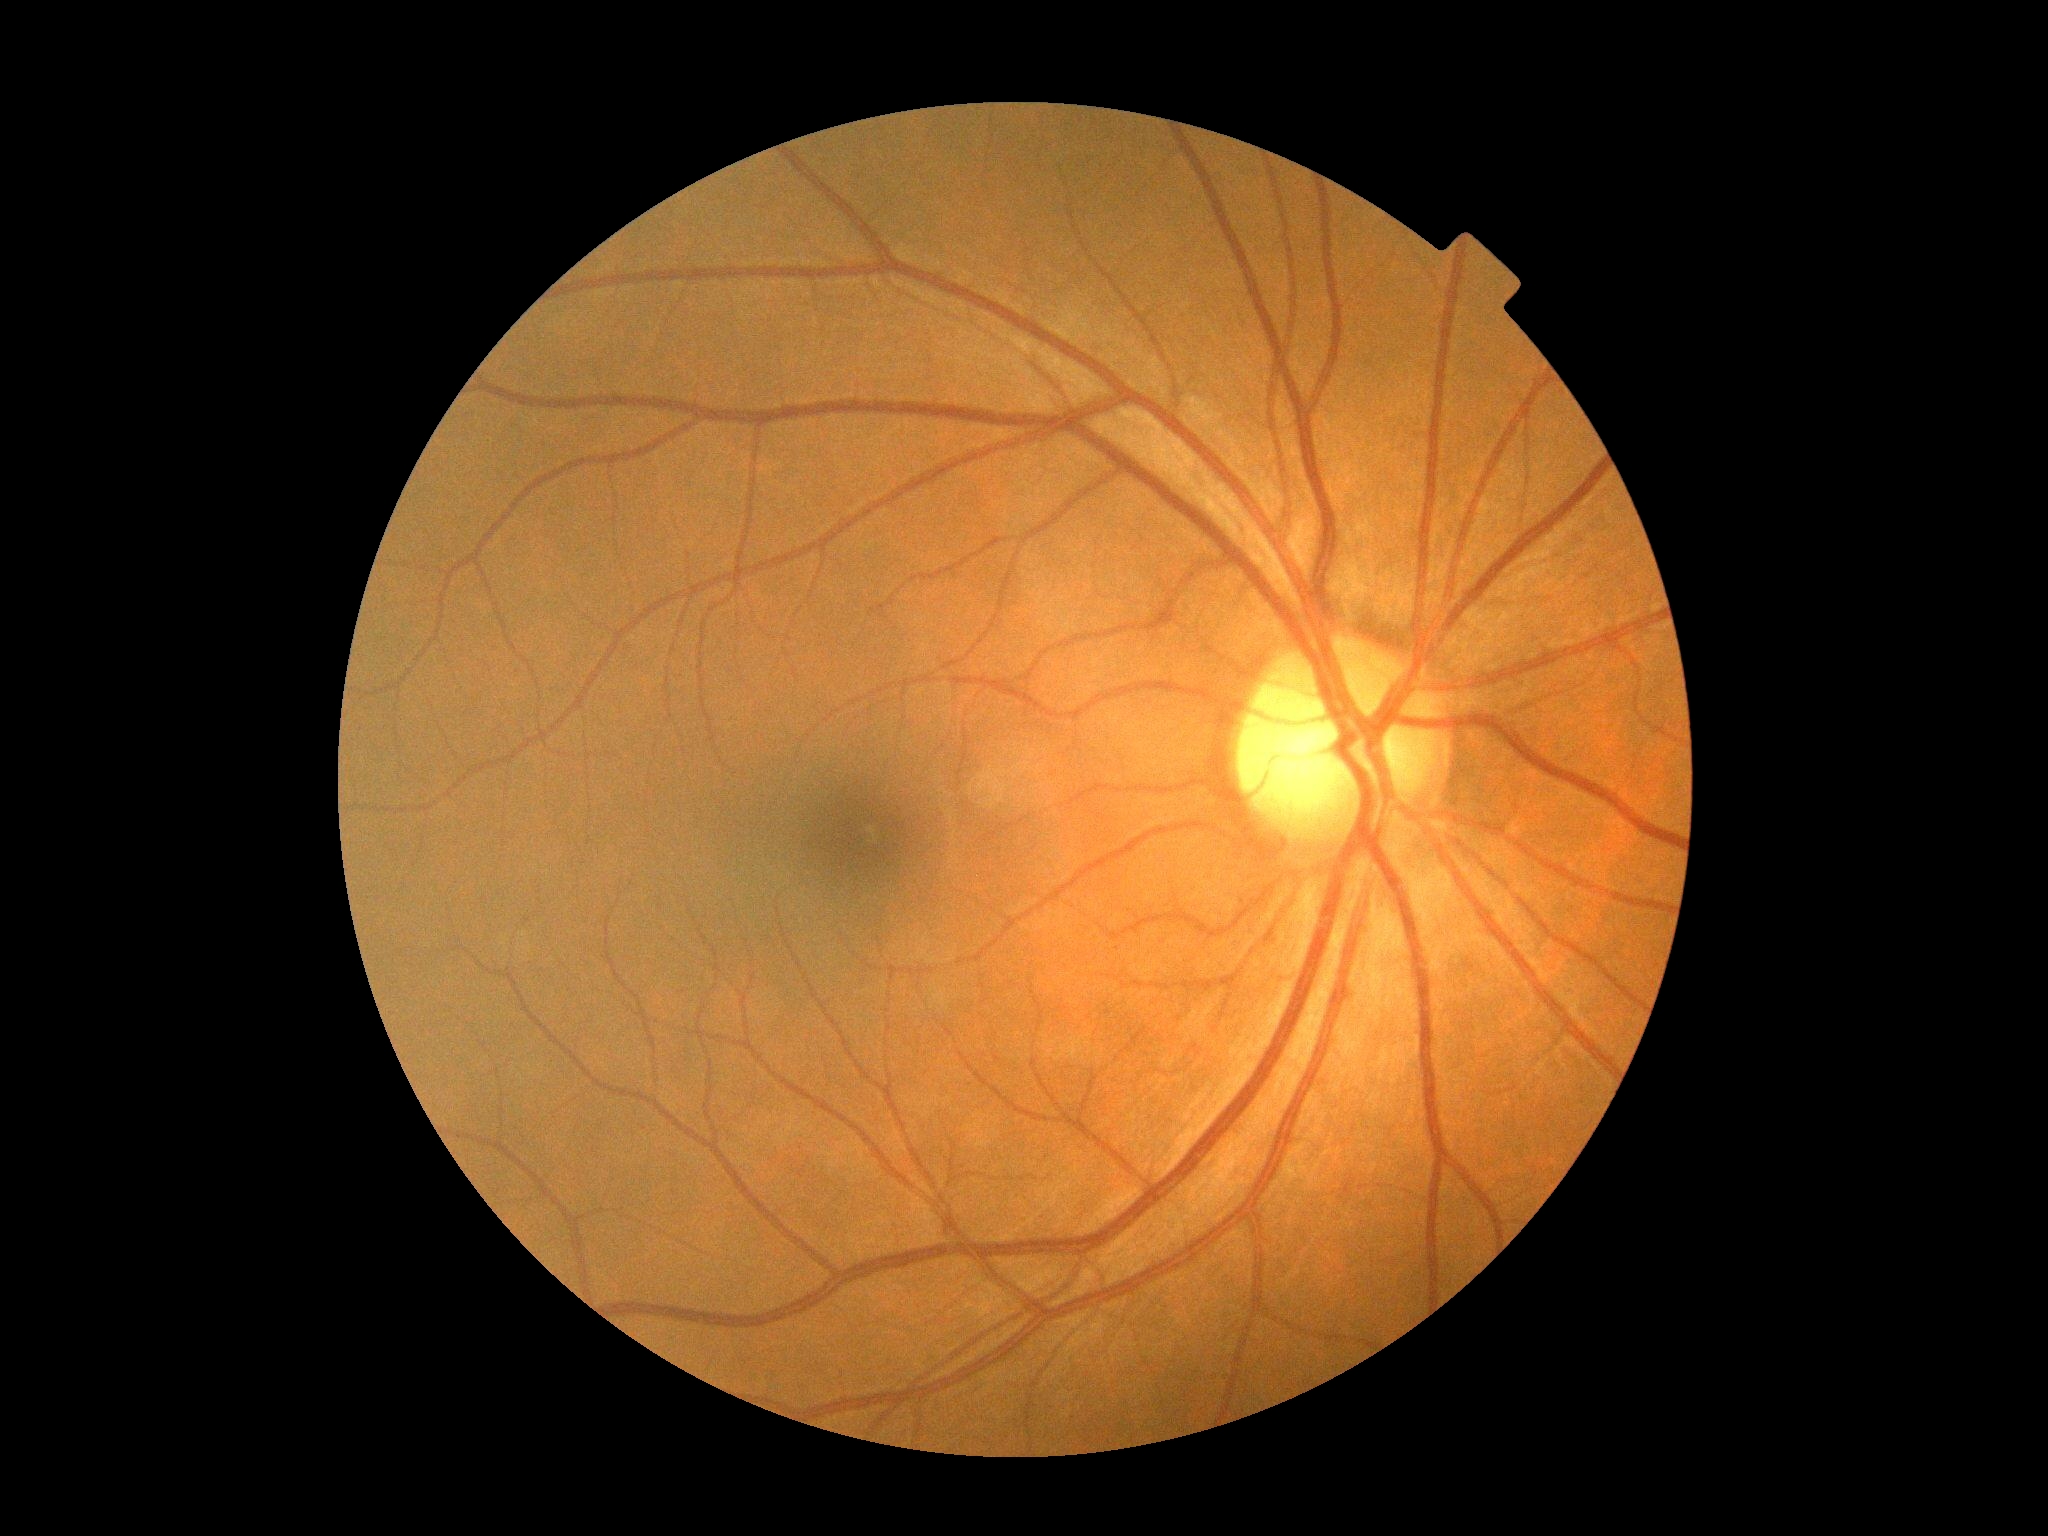 DR stage is grade 0.